Infant wide-field fundus photograph:
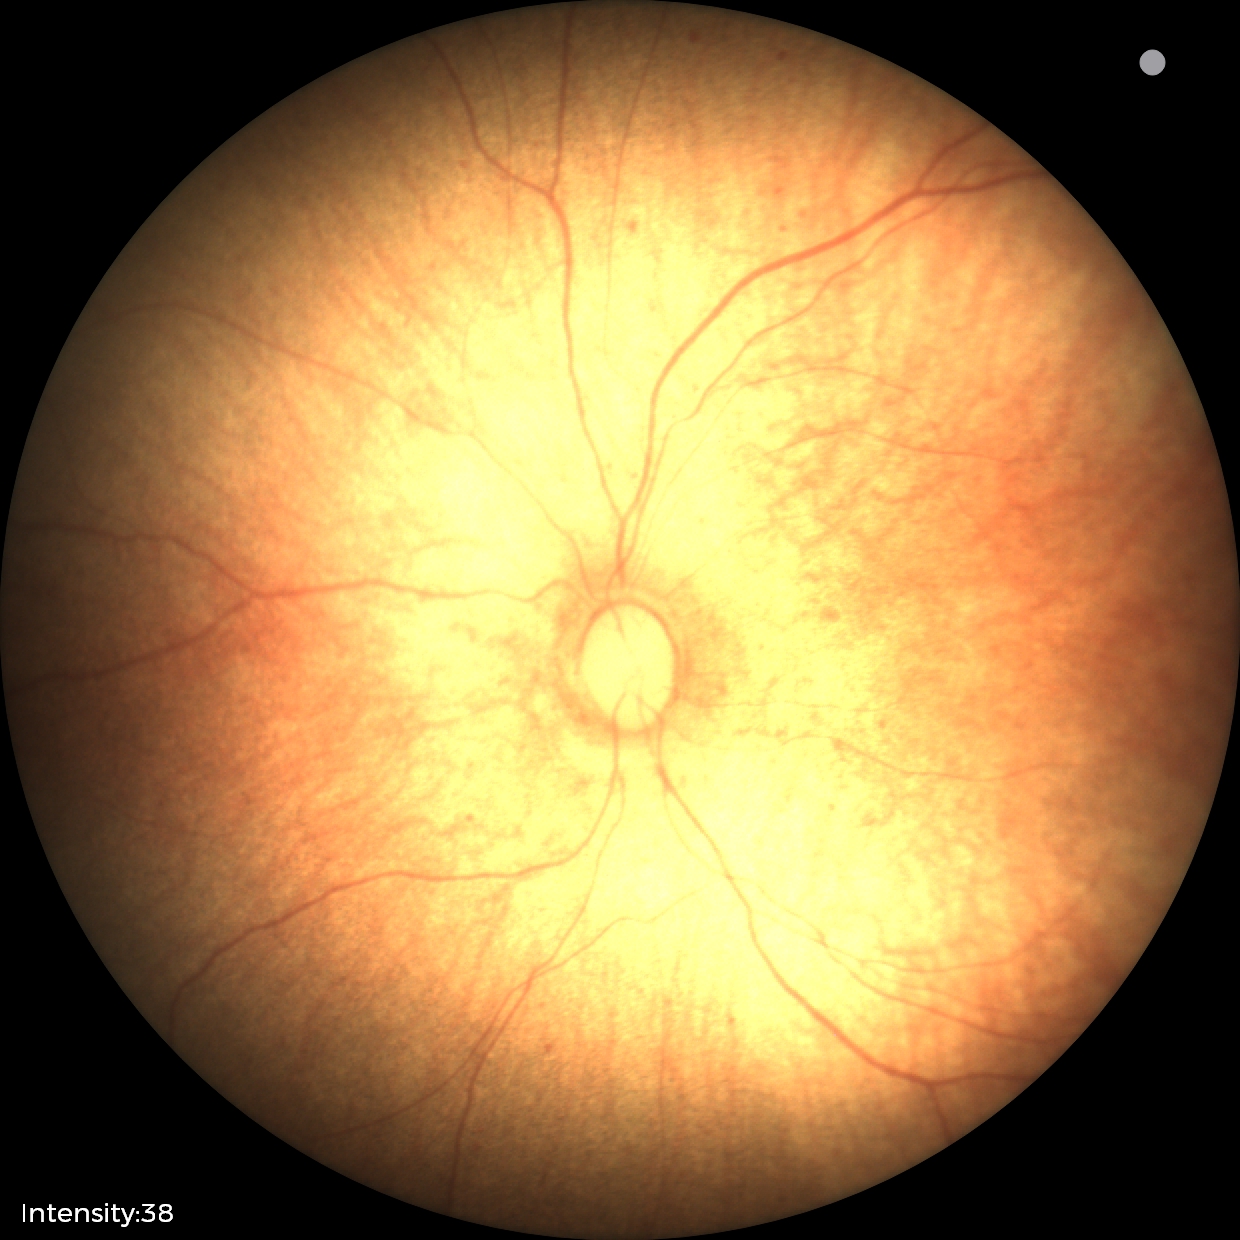 Physiological retinal appearance for postconceptual age.